2352x1568px. 45° field of view. CFP: 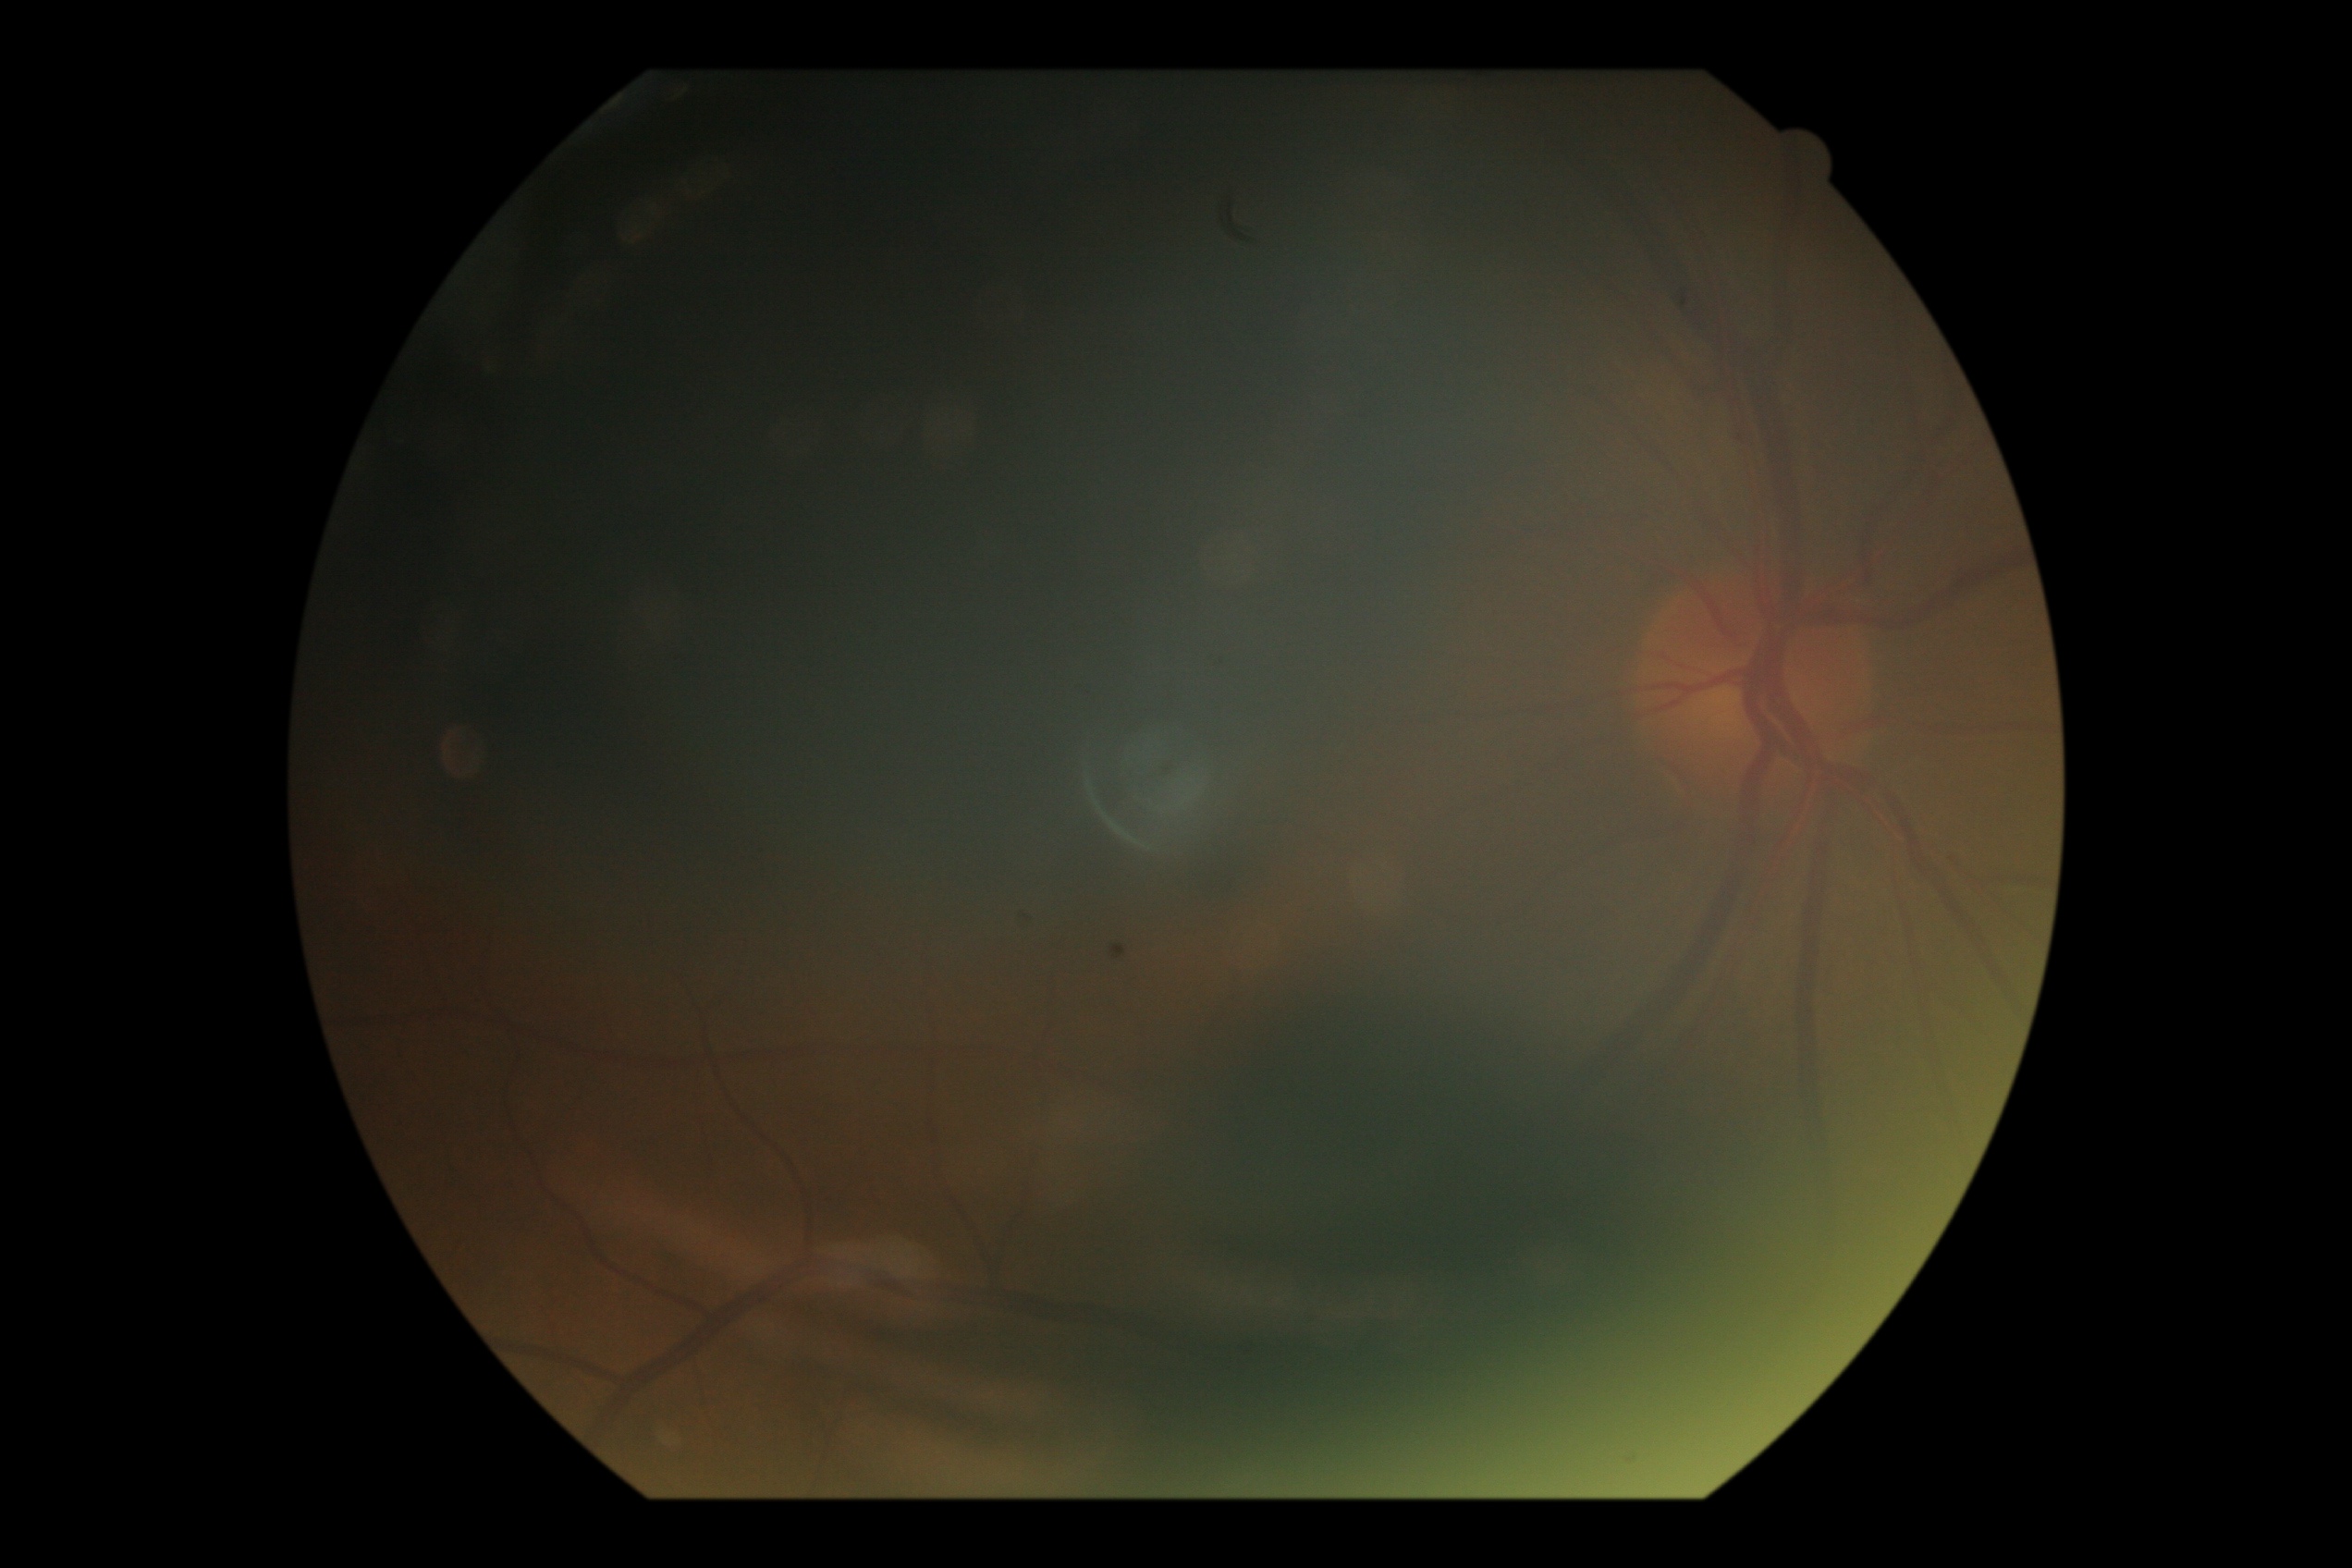

The image cannot be graded for diabetic retinopathy. Diabetic retinopathy (DR): ungradable.